Wide-field contact fundus photograph of an infant: 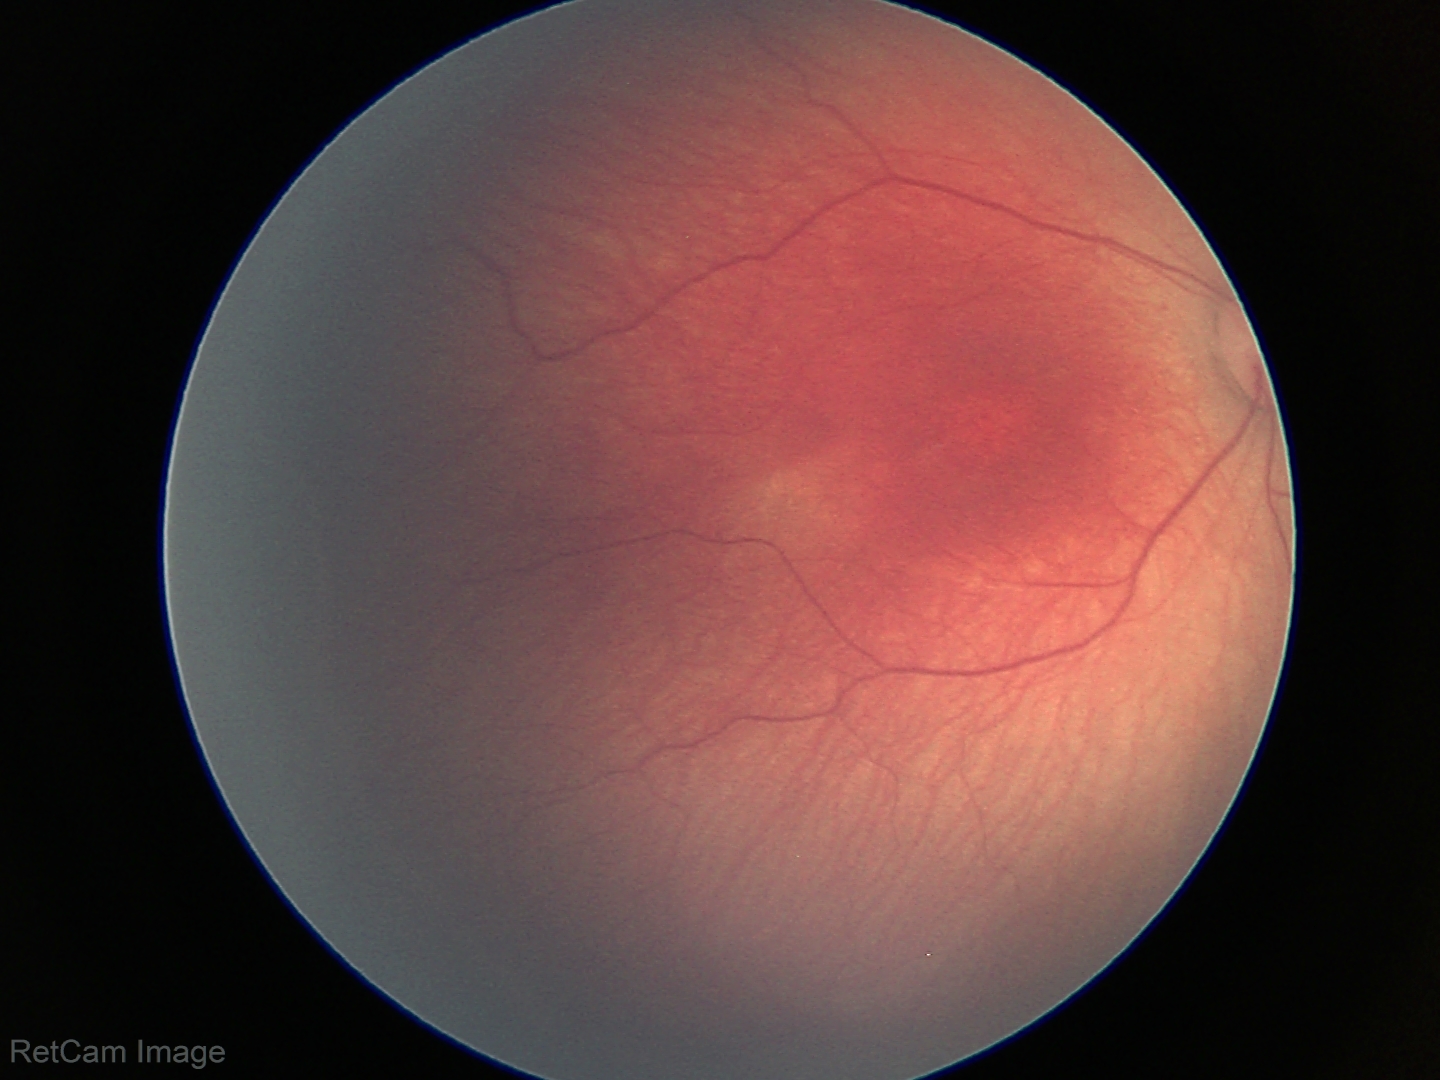
No plus disease.
Diagnosis from this screening exam: ROP stage 2.